2352 by 1568 pixels: 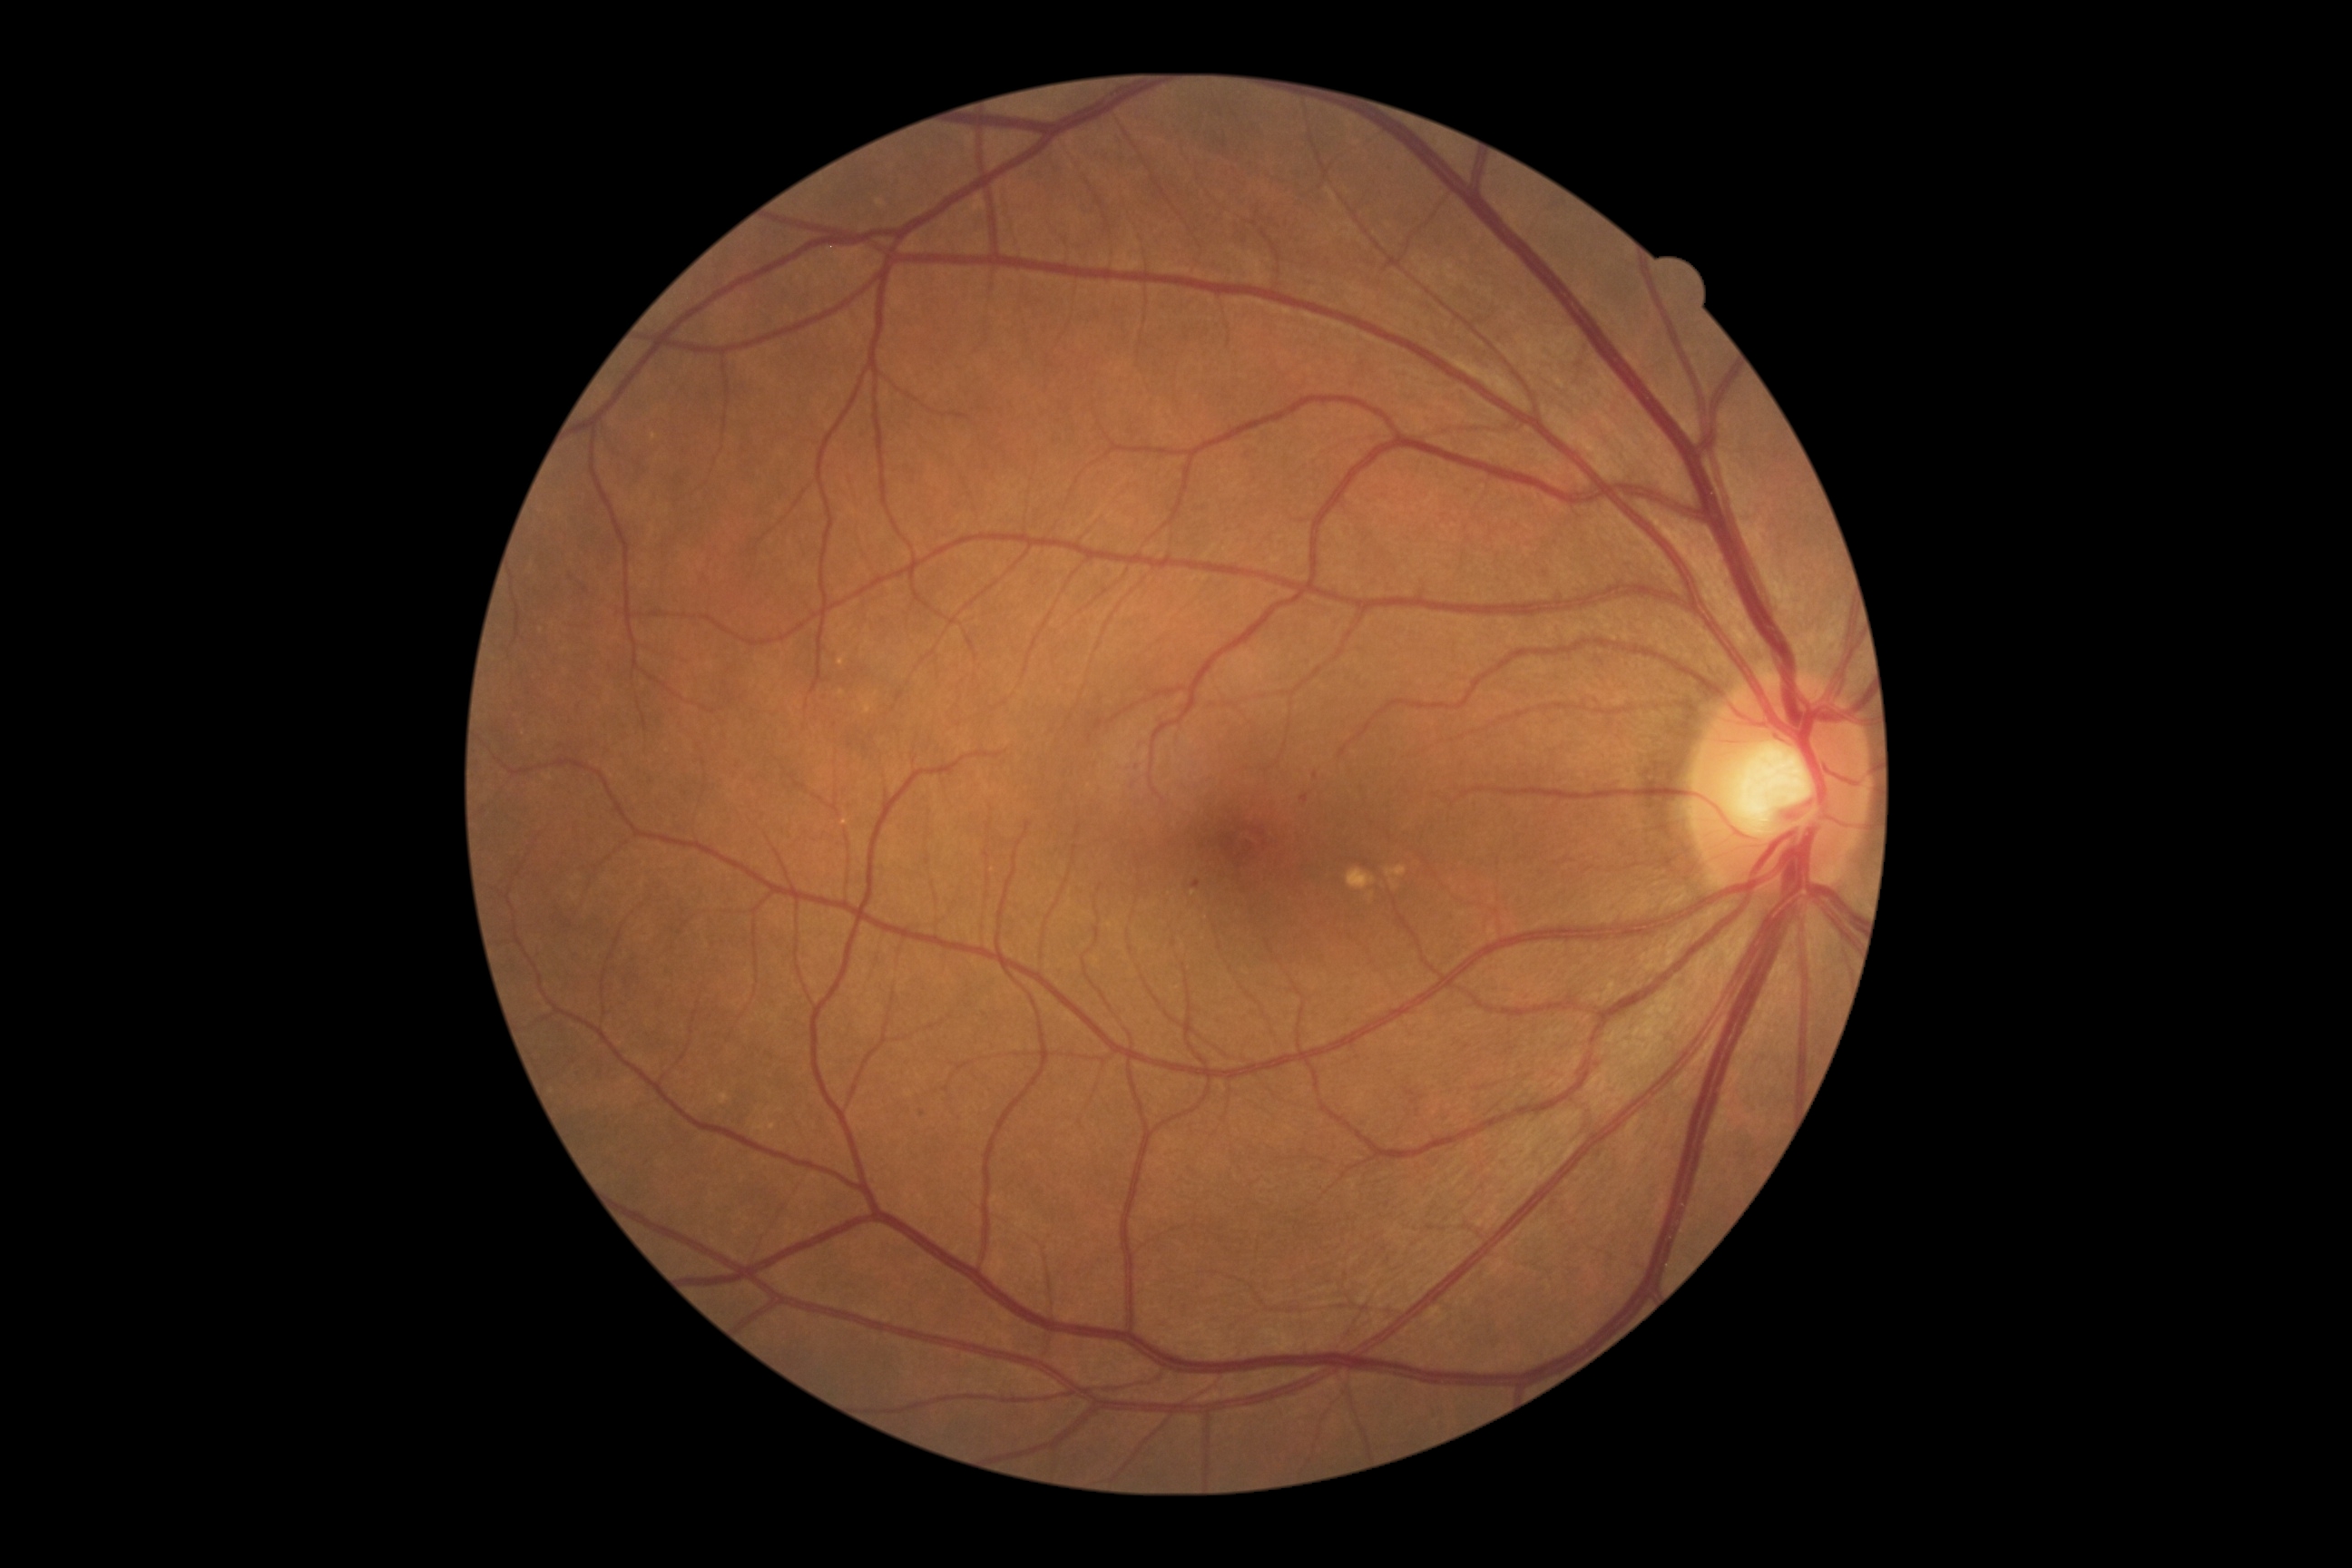
DR grade is 1 — presence of microaneurysms only
Findings:
- SEs: none
- MAs (small, approximate centers) near {"x": 1196, "y": 884} | {"x": 1305, "y": 799} | {"x": 1315, "y": 775} | {"x": 923, "y": 1113}
- EXs: none
- HEs: none